Central posterior field · 50° field of view · CFP · pupil-dilated · 2228 by 1652 pixels · acquired with a Topcon TRC-50DX:
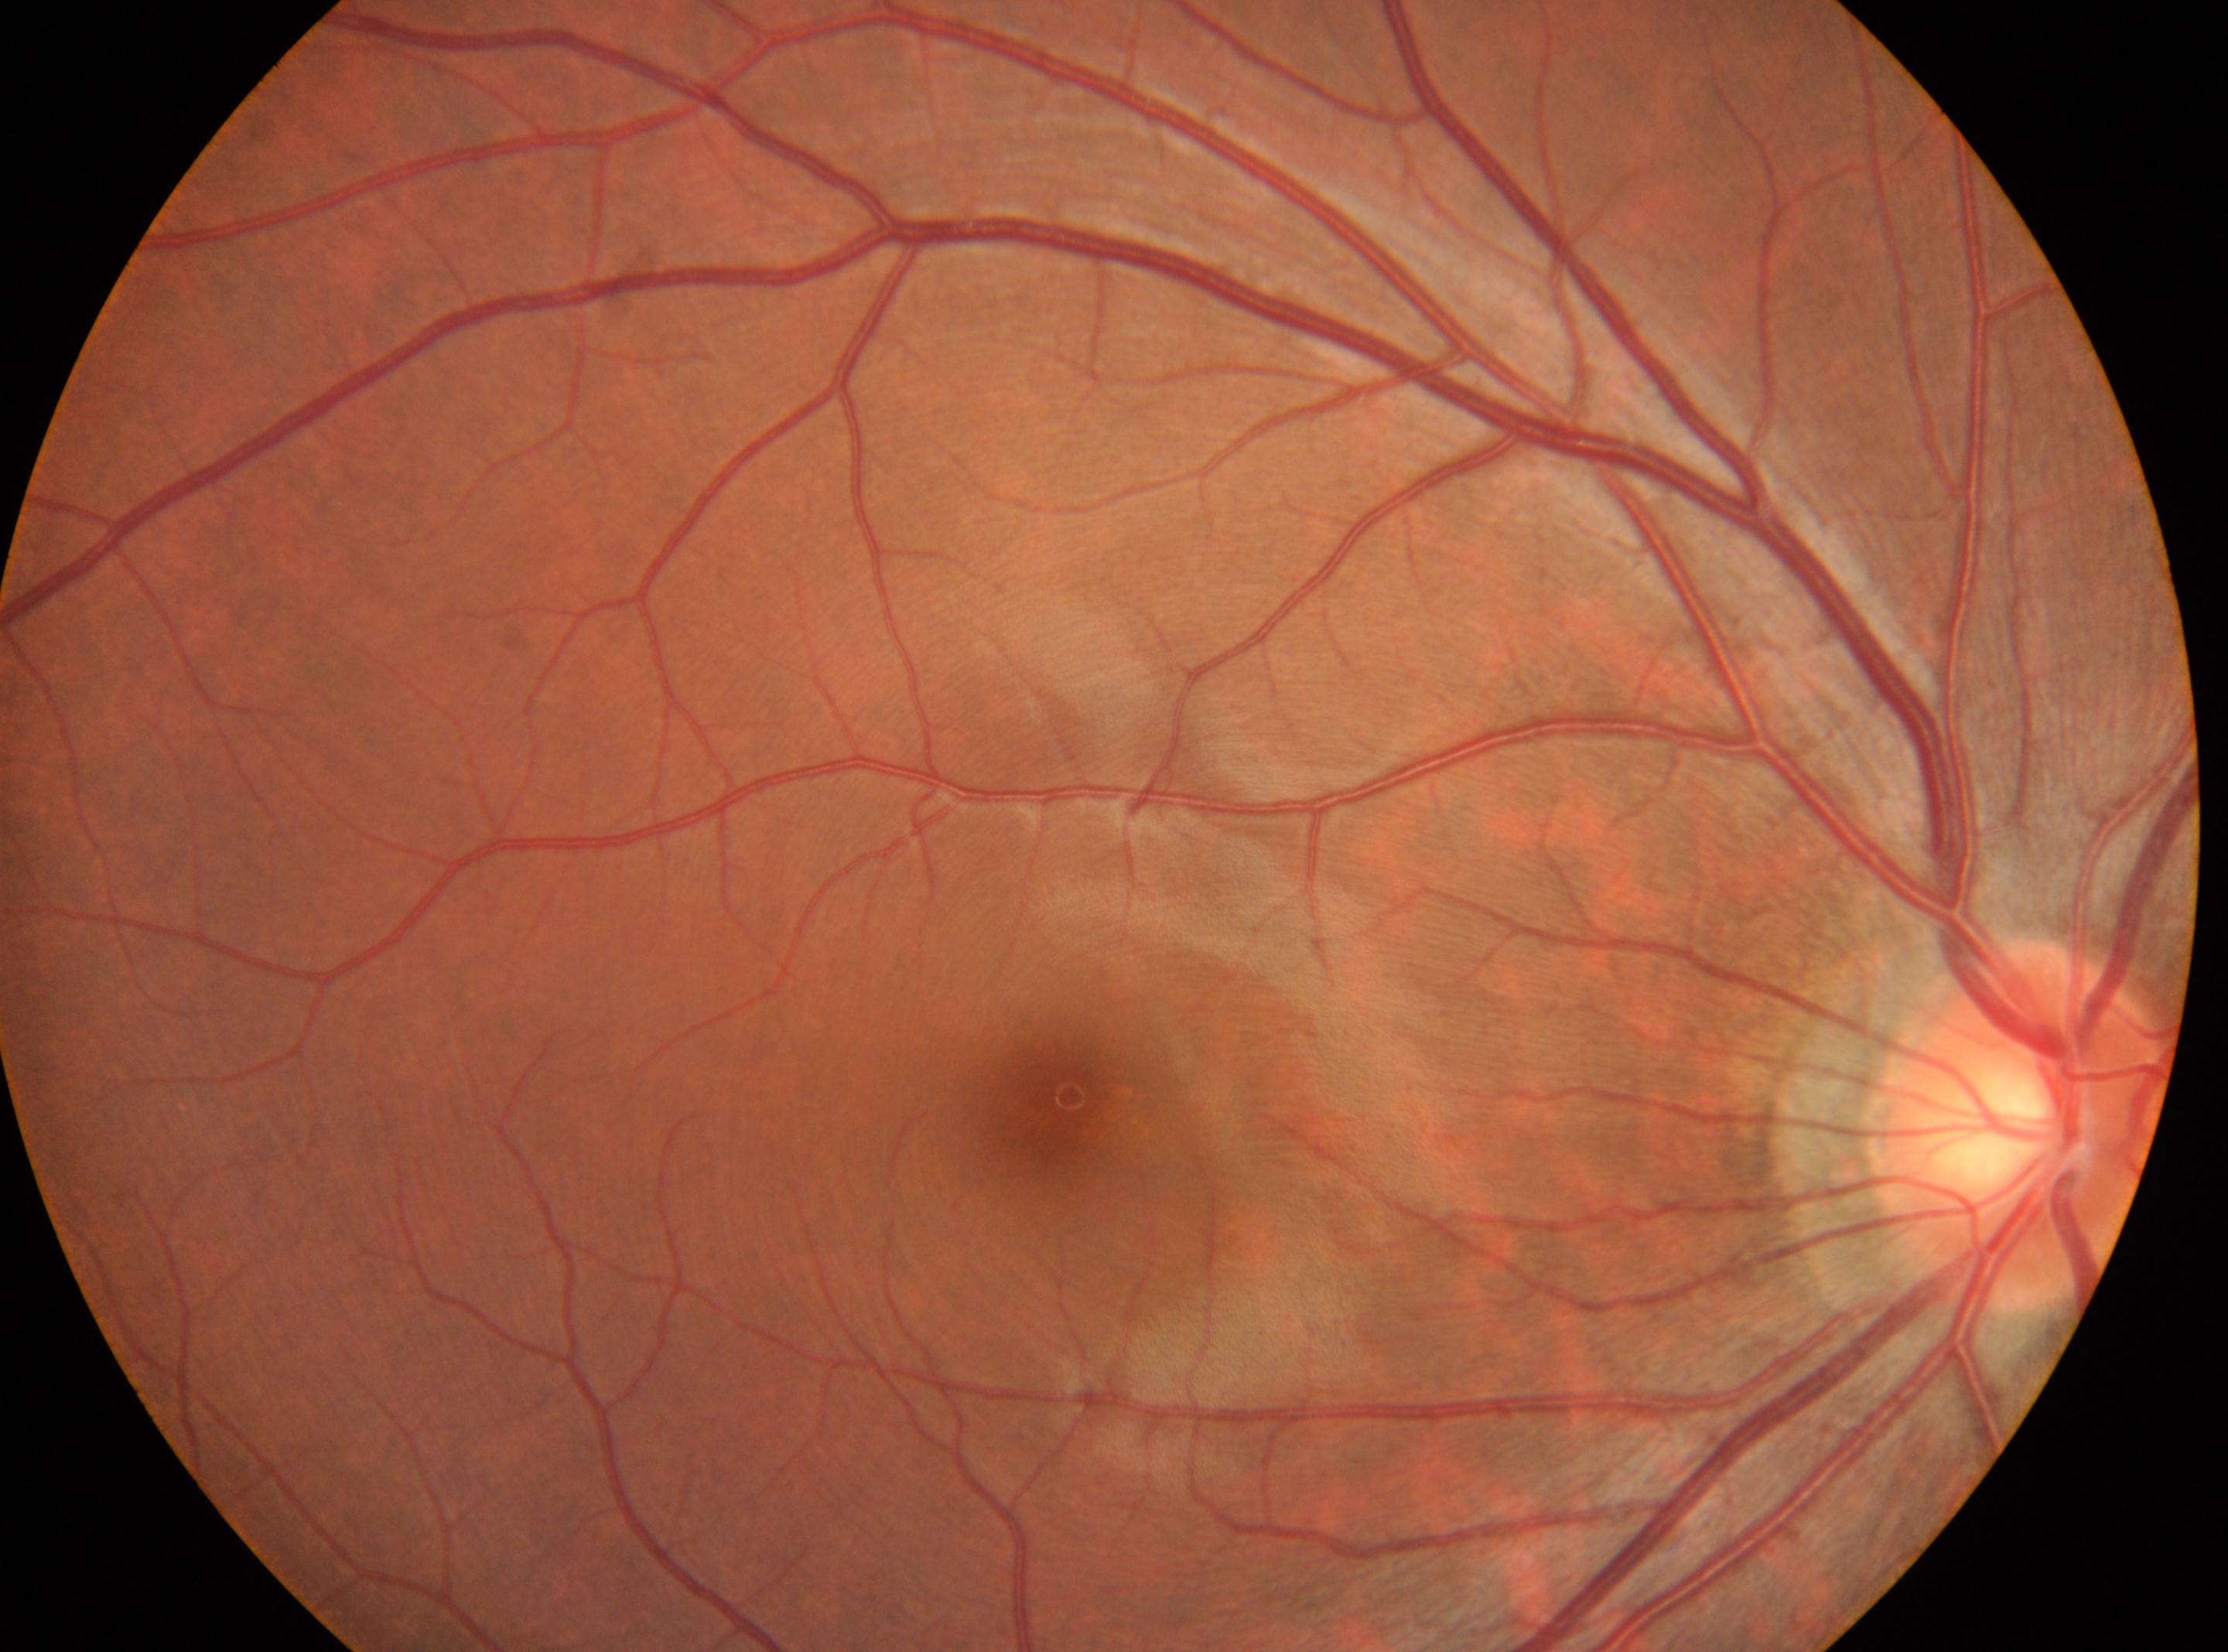
The fovea is at 1064, 1101. This is the oculus dexter. Diabetic retinopathy (DR) is grade 0 (no apparent retinopathy). ONH located at 2025, 1121.